1659x2212, captured on a Remidio Fundus on Phone — 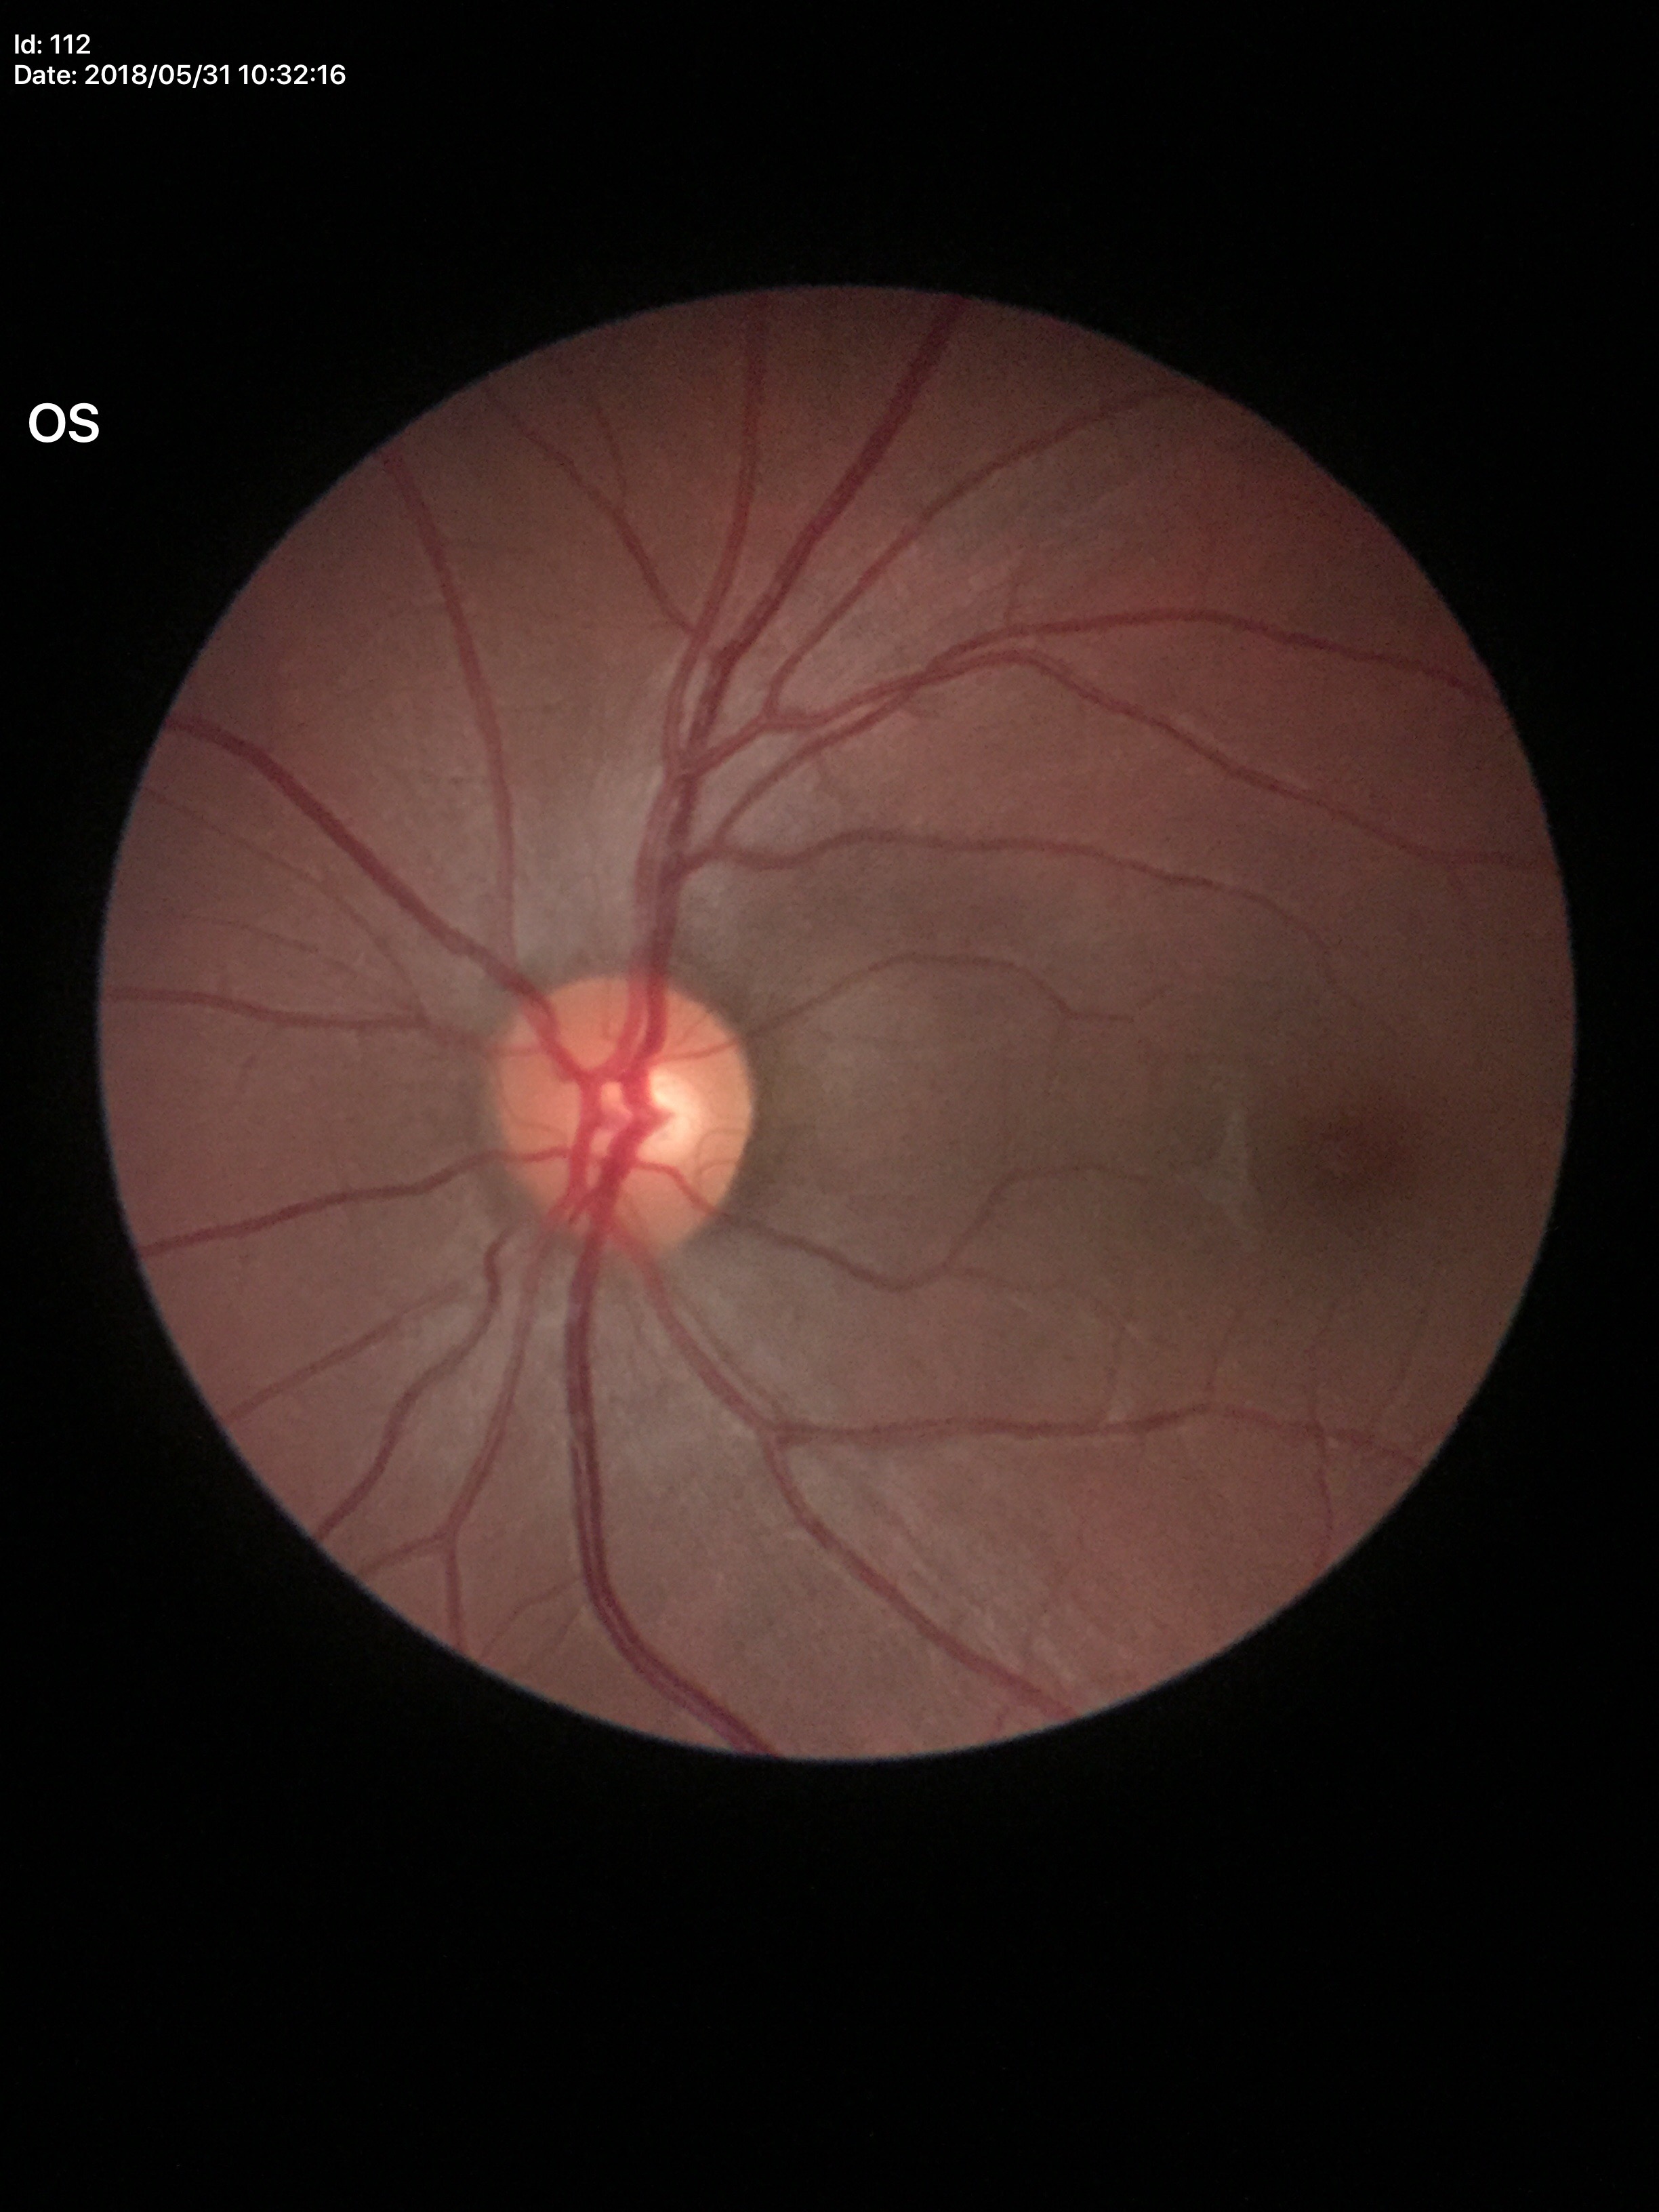

{
  "vcdr": "0.46",
  "glaucoma_decision": "no suspicious findings (5/5 ophthalmologists in agreement)"
}